Nonmydriatic · posterior pole photograph · camera: NIDEK AFC-230:
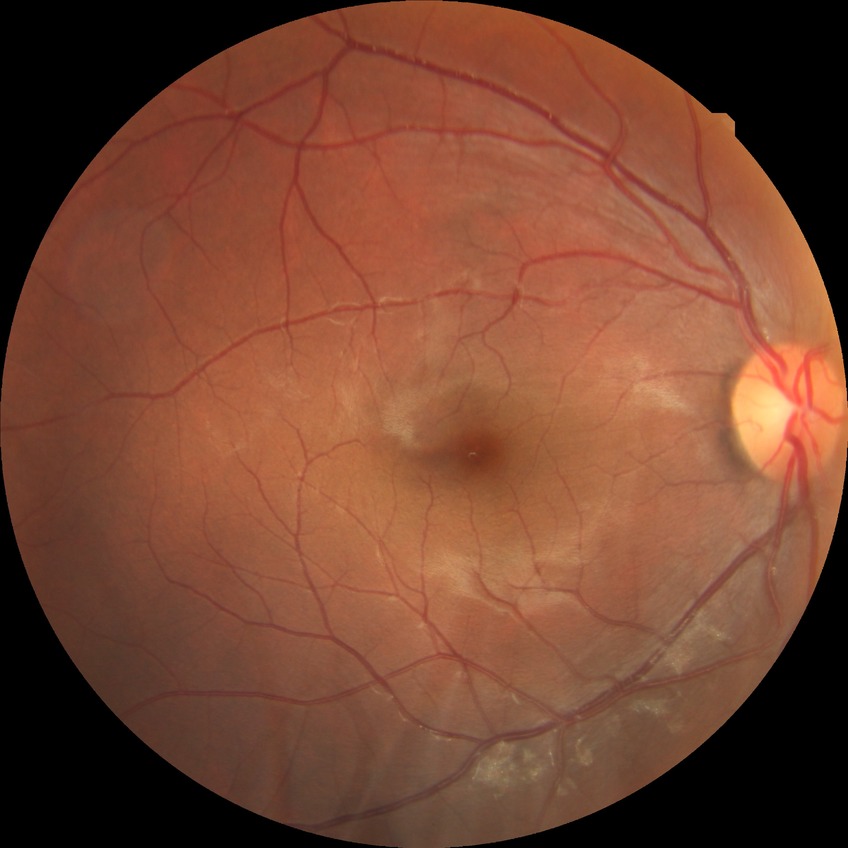
Davis DR grade: NDR.